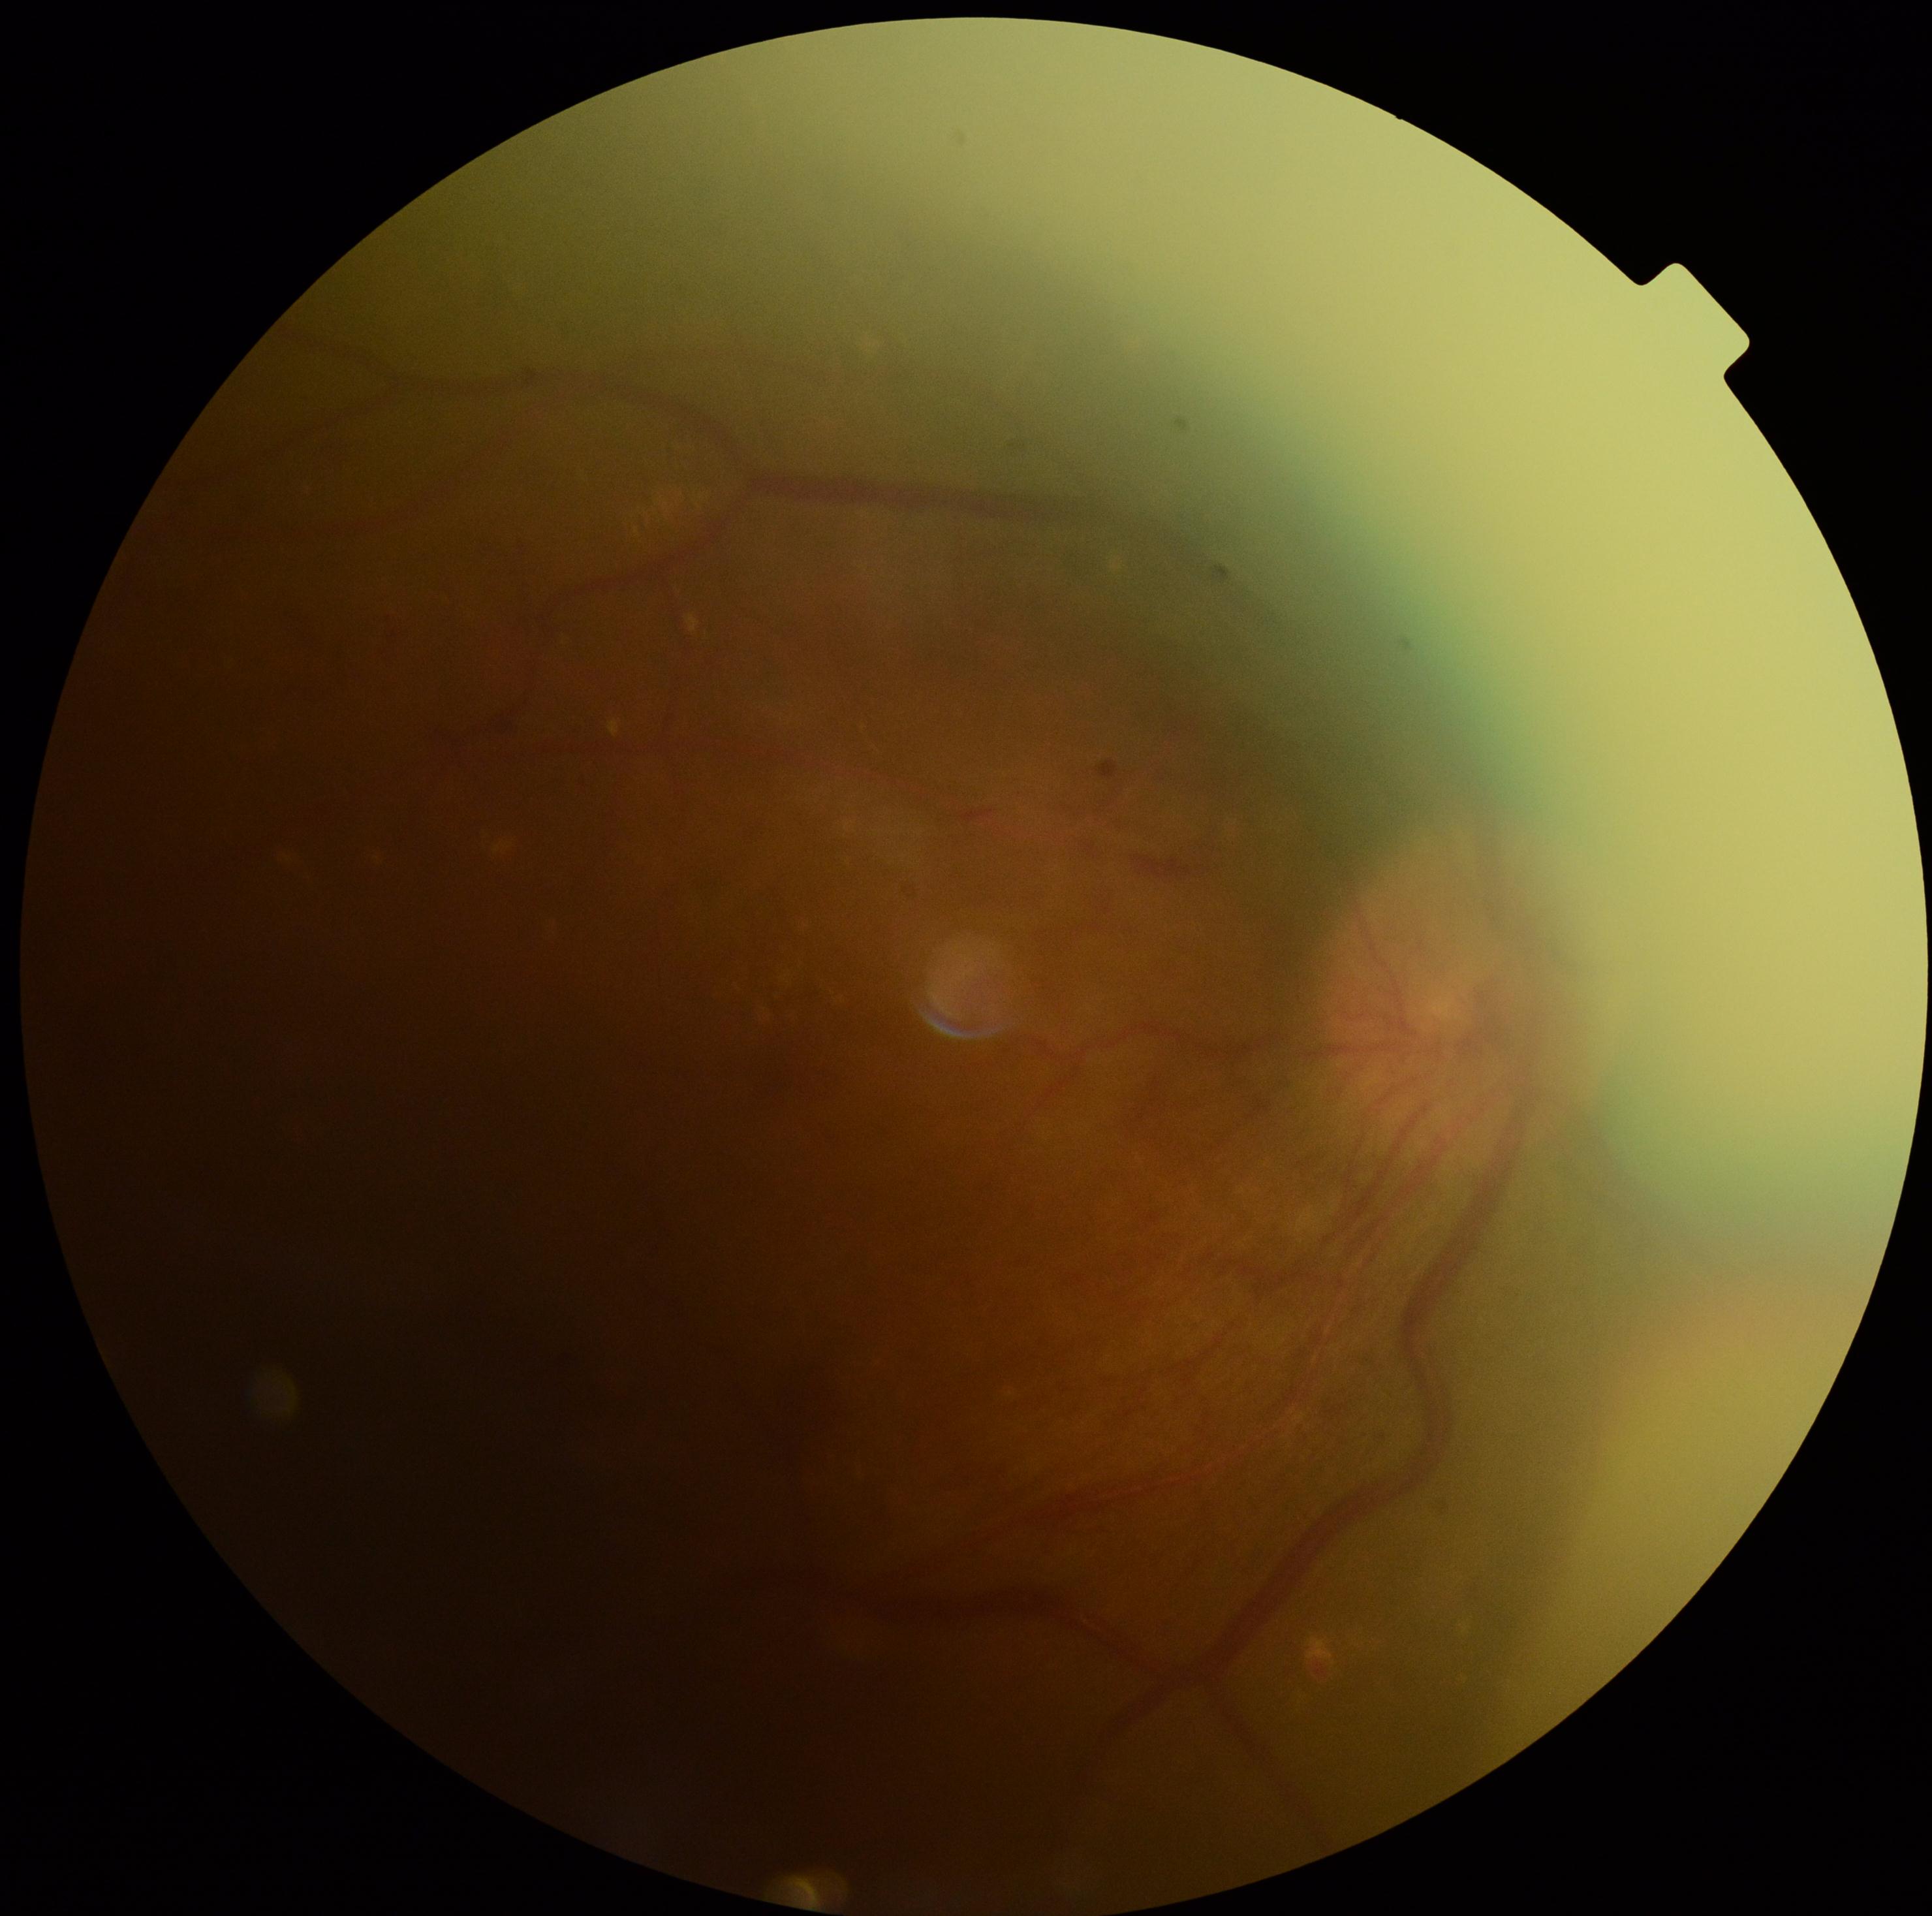

diabetic retinopathy (DR) = grade 4 — neovascularization and/or vitreous/pre-retinal hemorrhage.